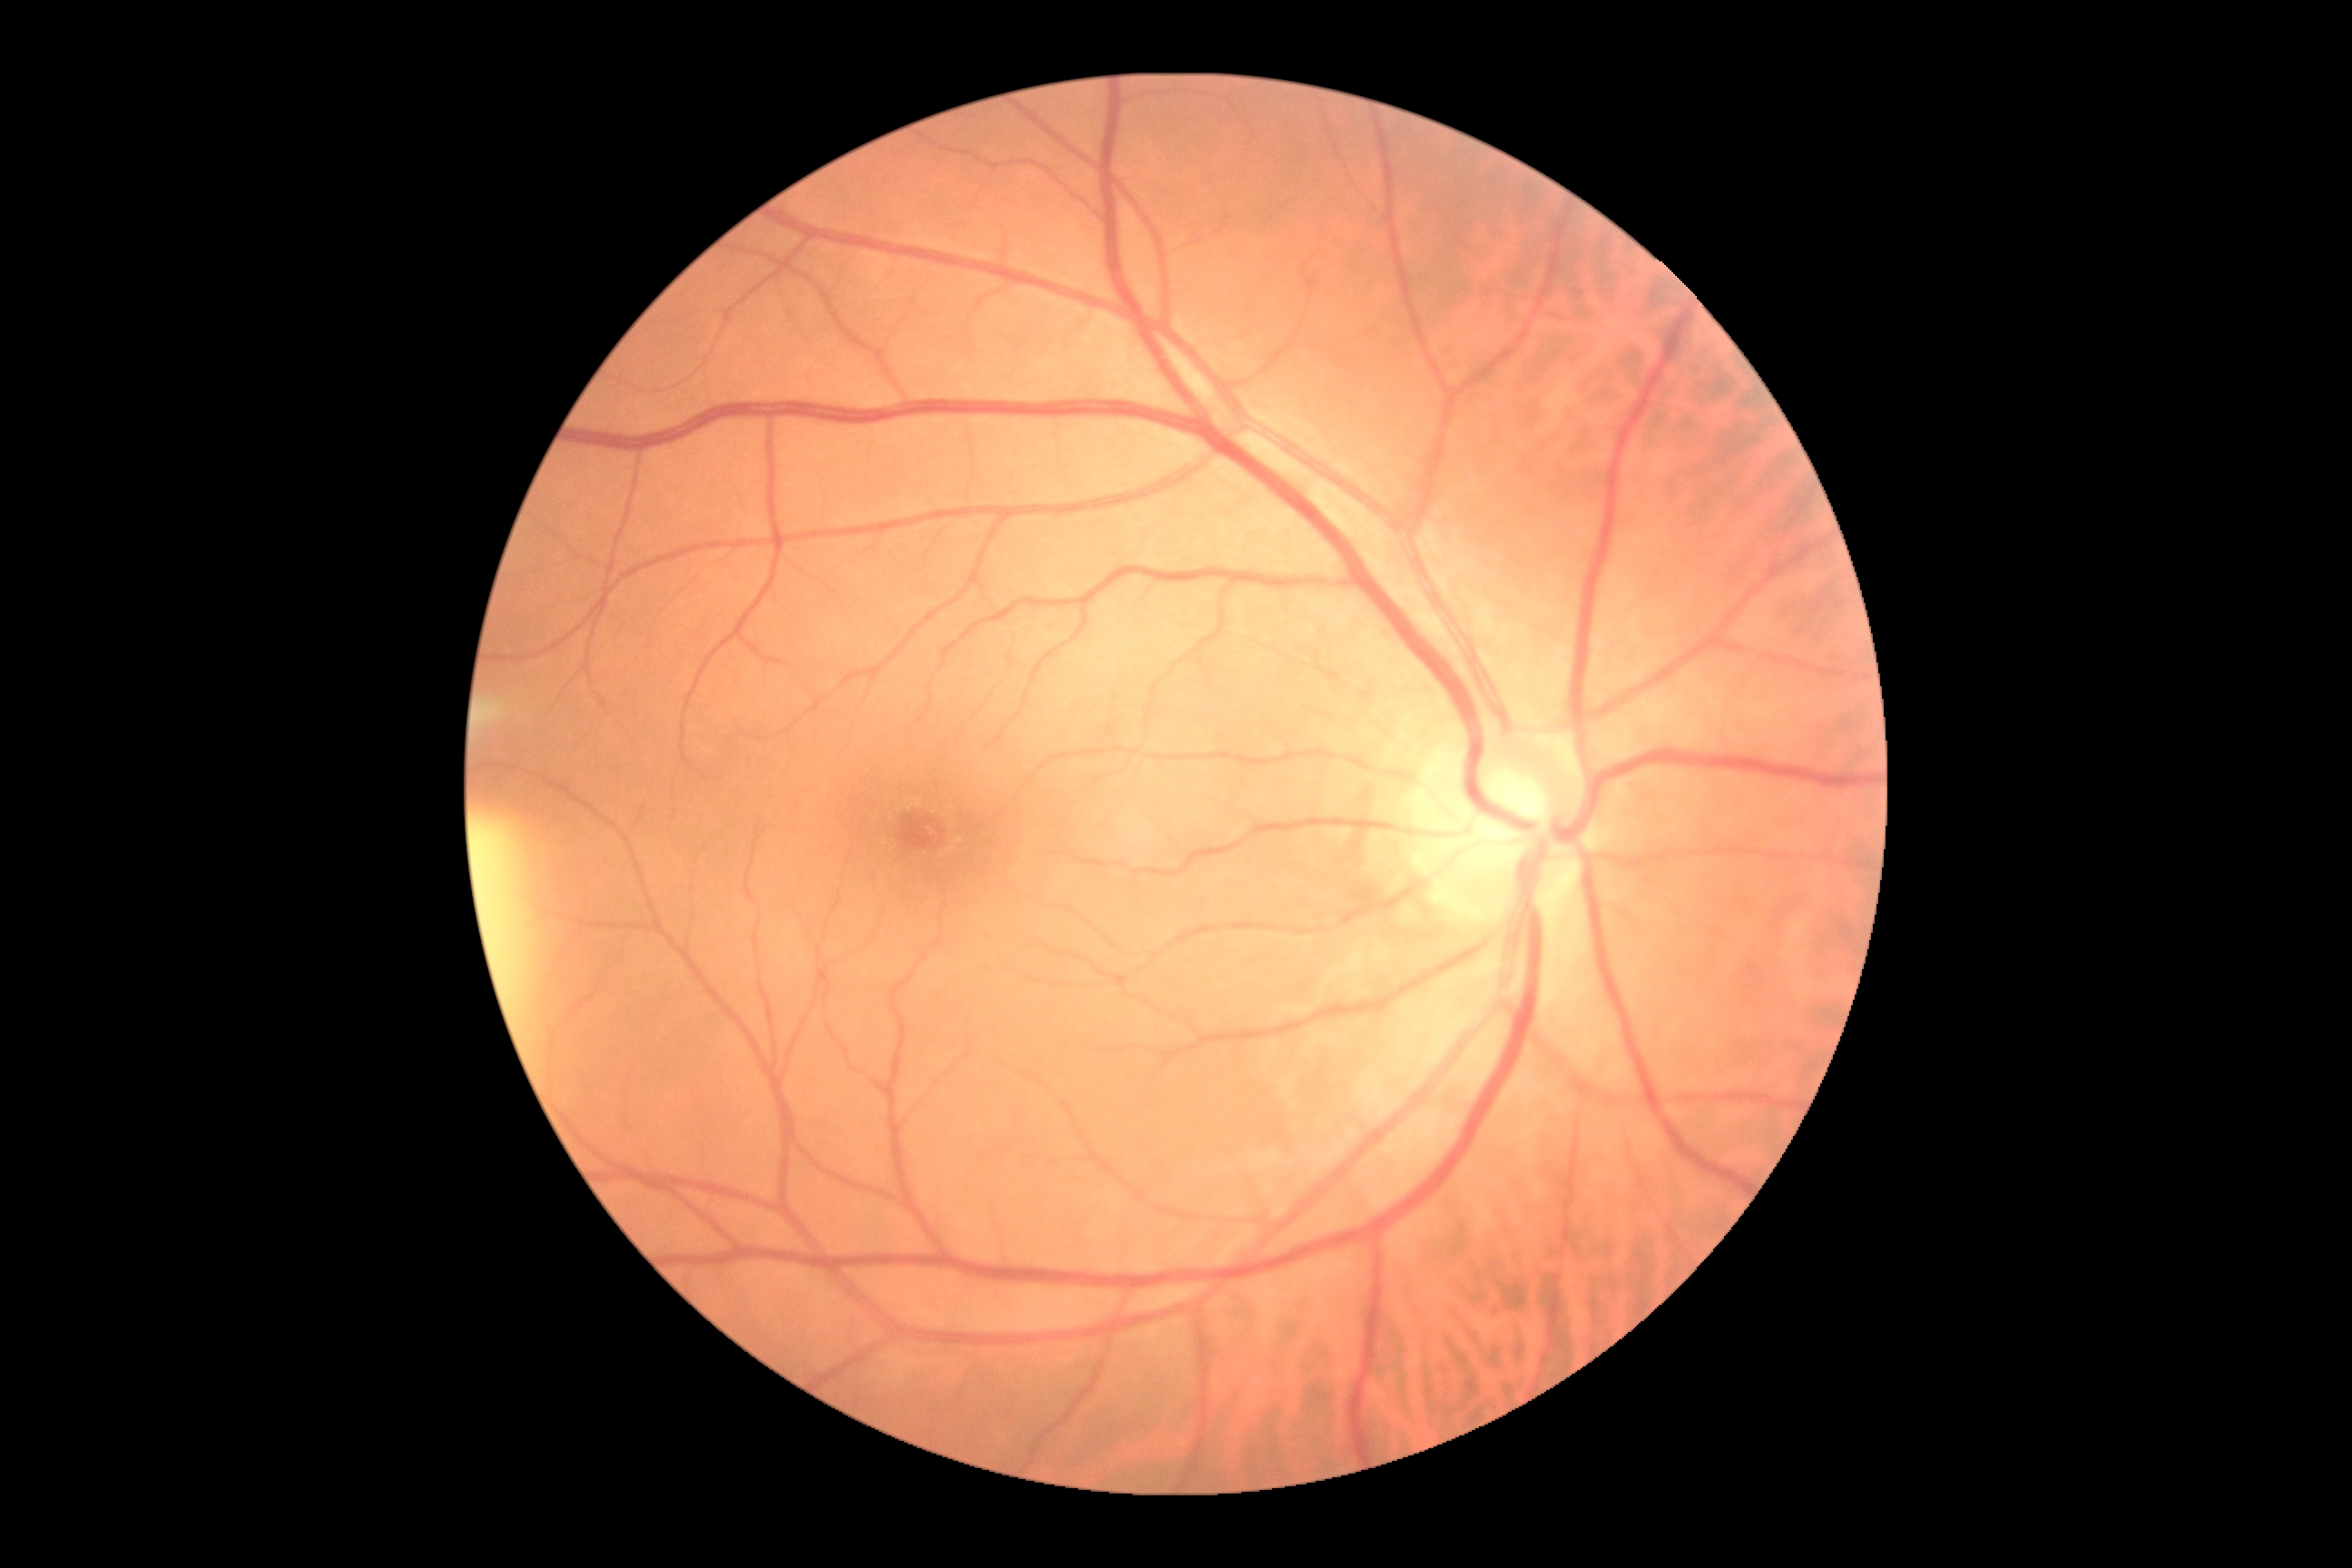

DR grade = 0 (no apparent retinopathy), DR impression = no apparent DR.